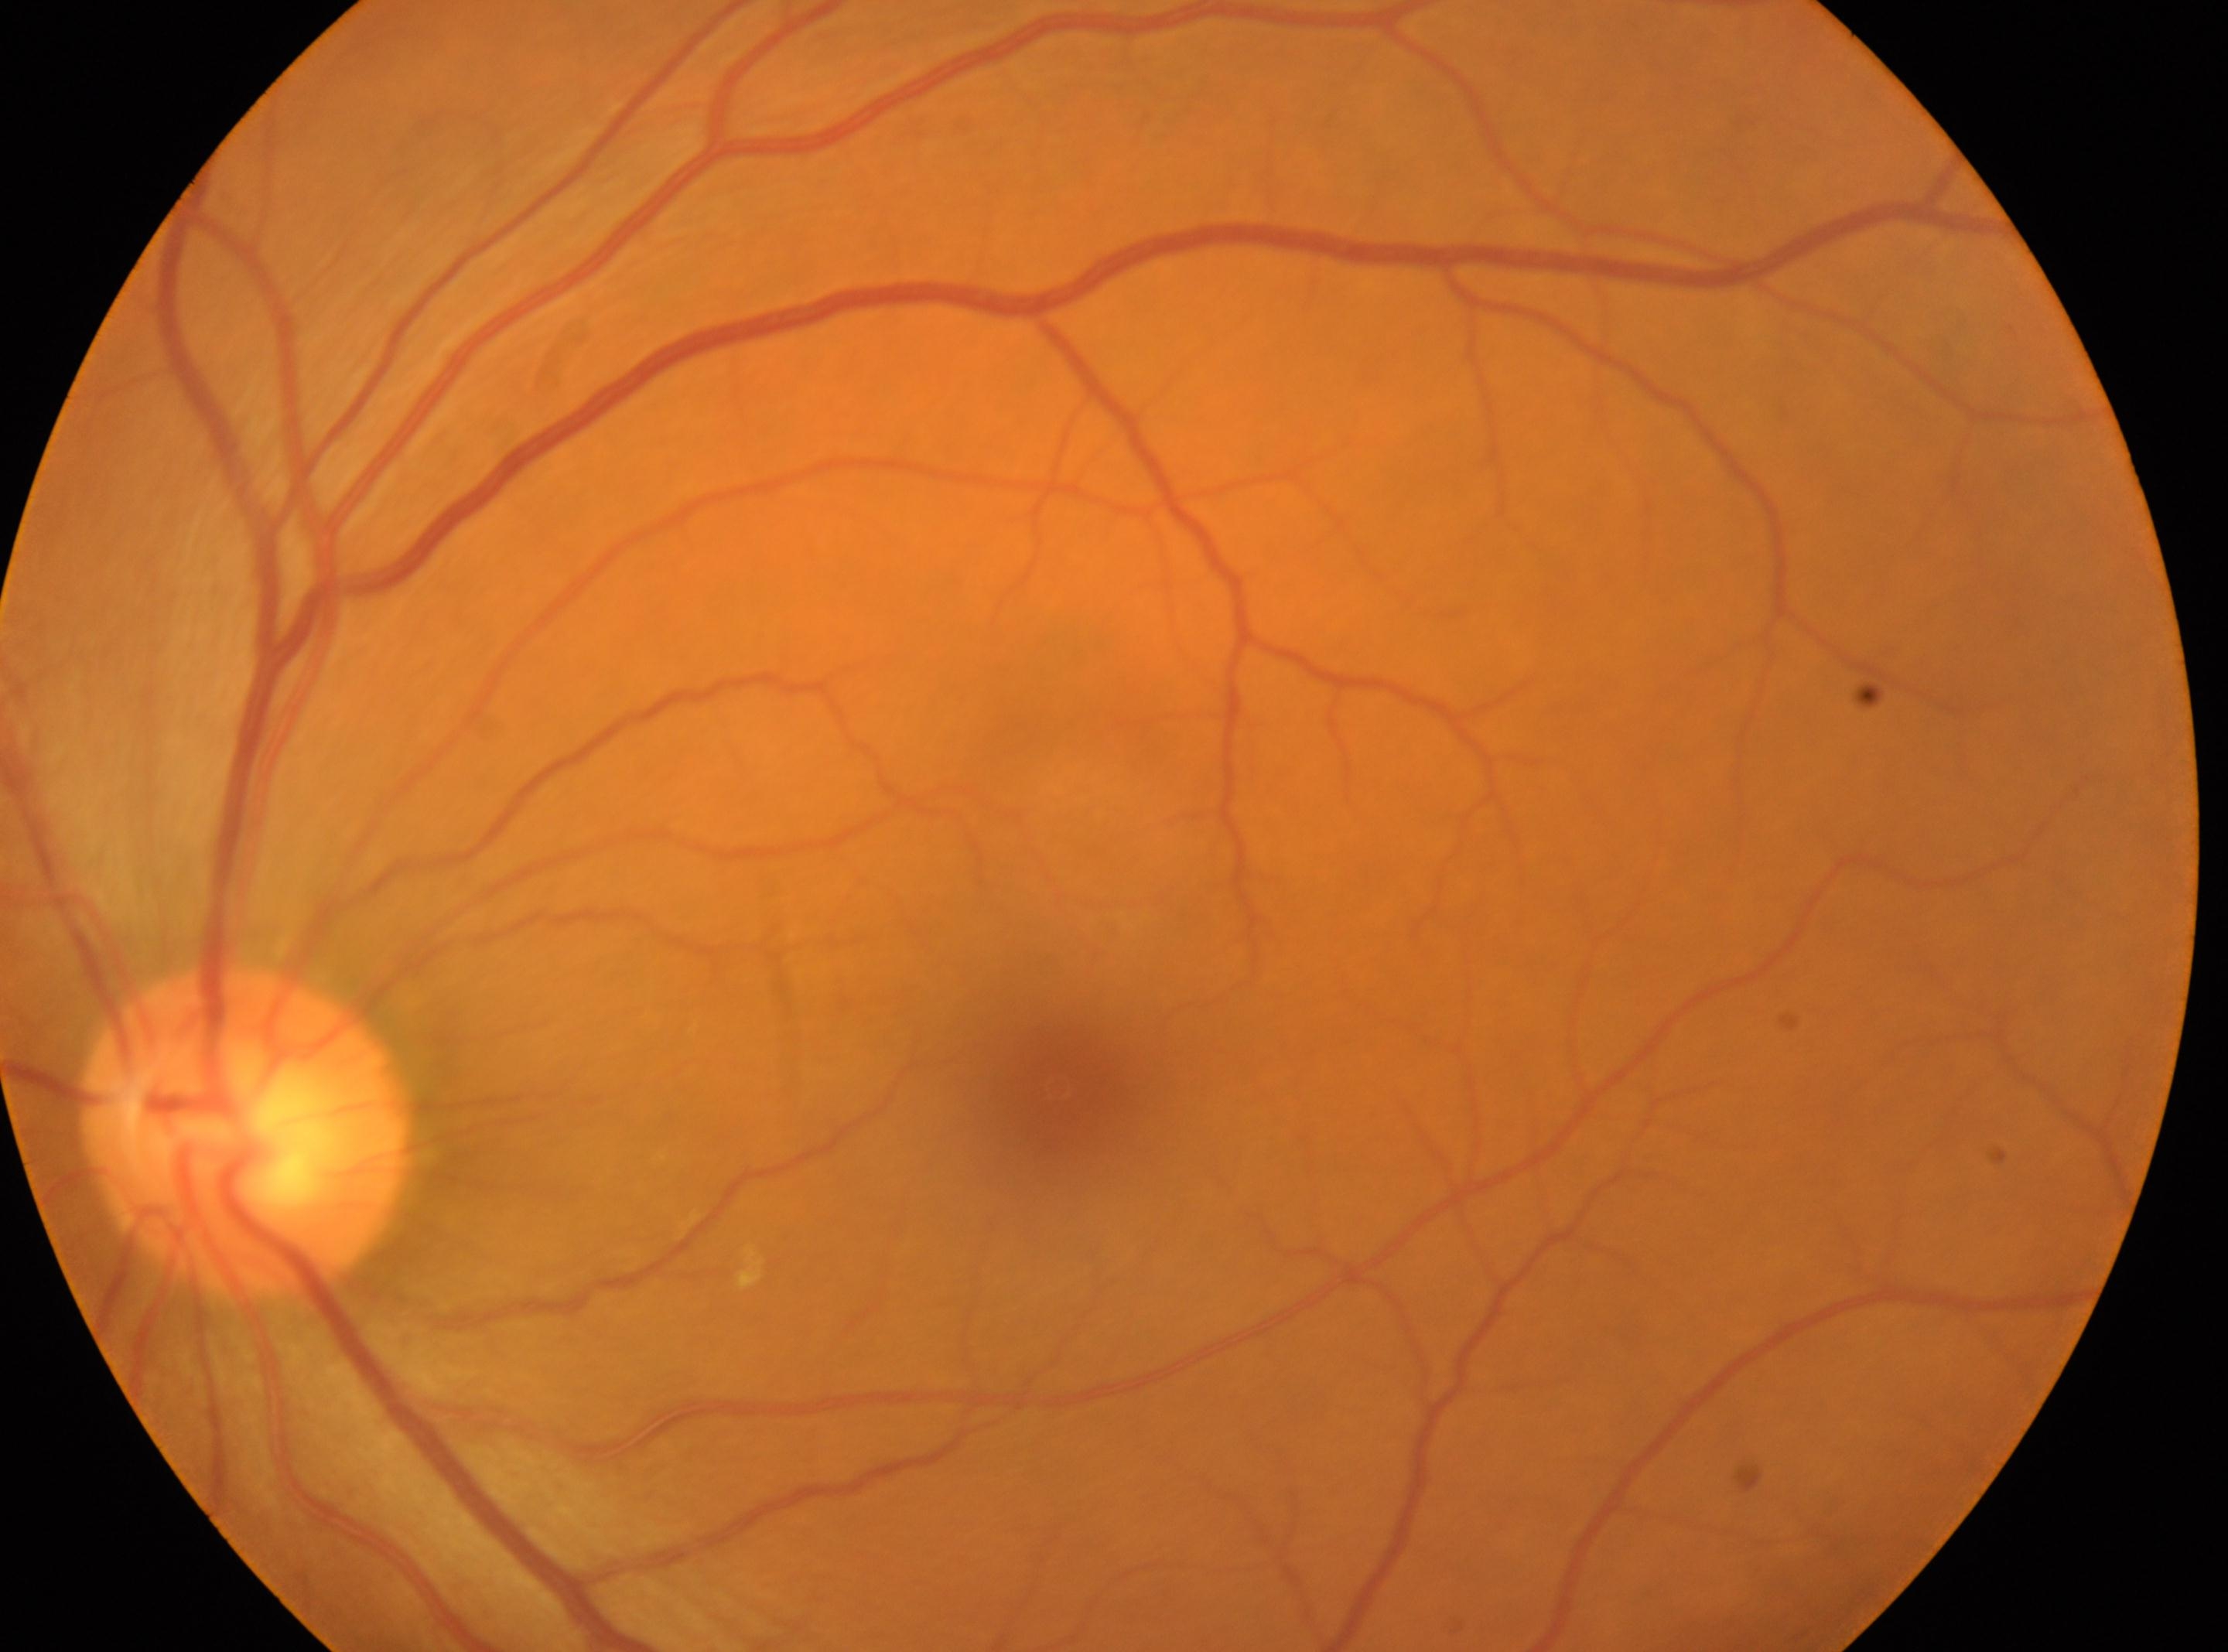
DR stage = grade 0 — no visible signs of diabetic retinopathy, foveal center = (1060, 1086), optic disc = (248, 1131), laterality = left.